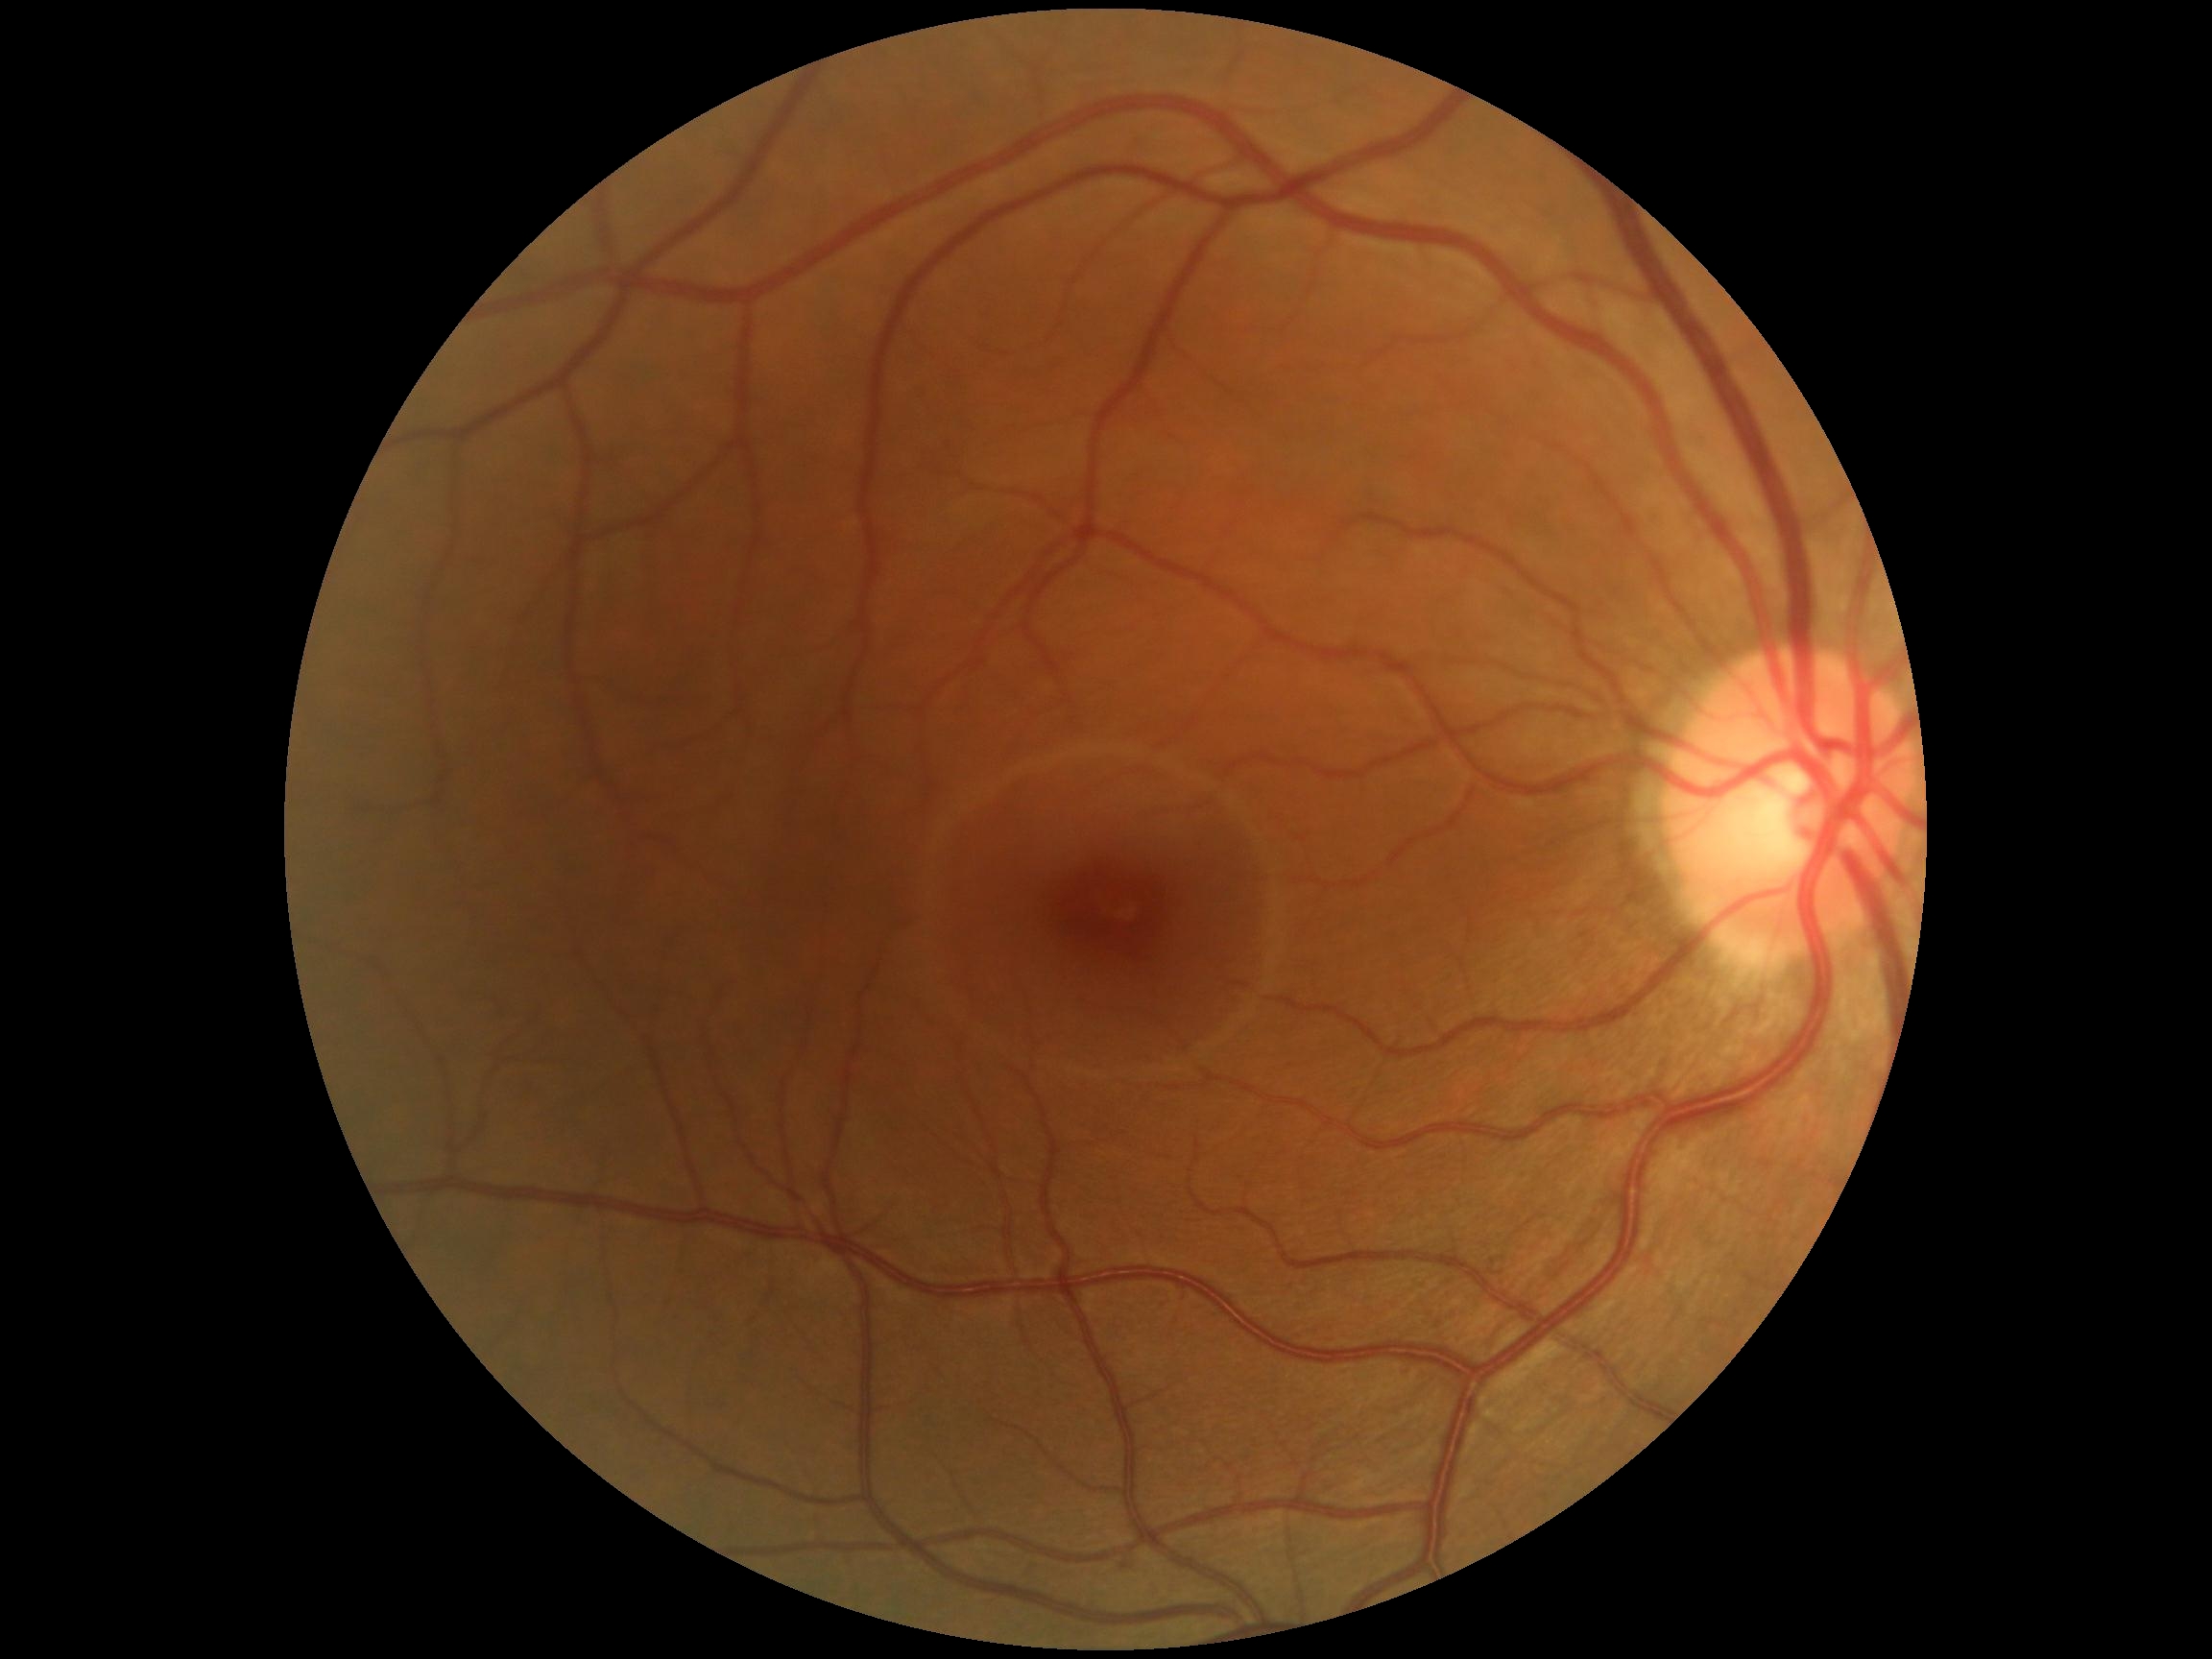

Diabetic retinopathy severity: 0/4. No DR findings.